Posterior pole color fundus photograph.
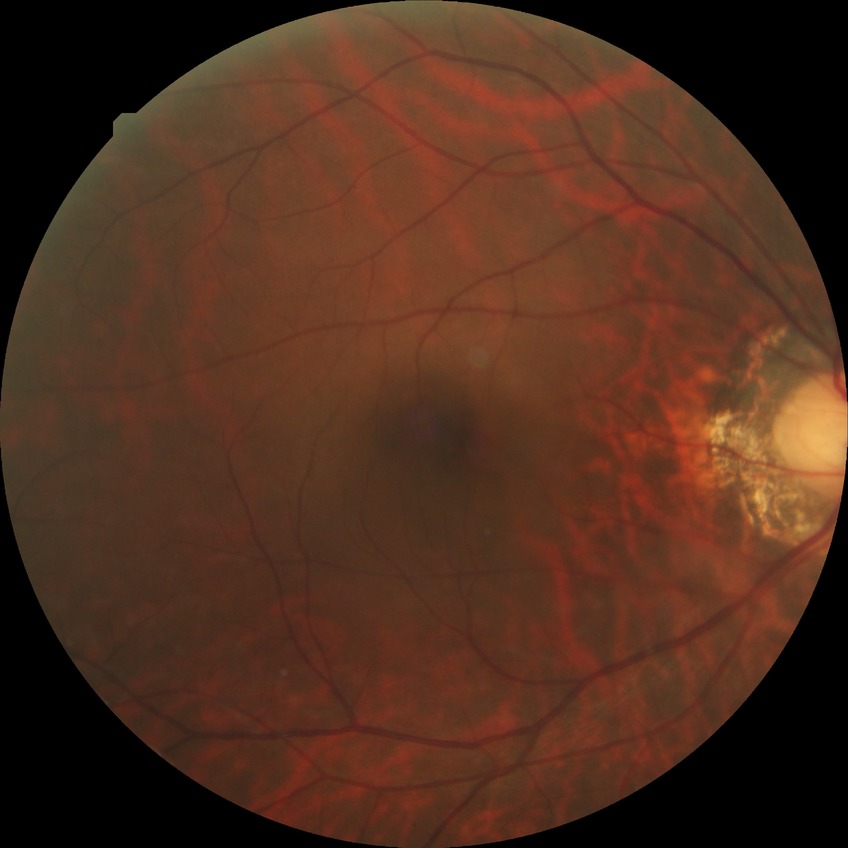 Retinopathy grade is no diabetic retinopathy.